1932x1932: 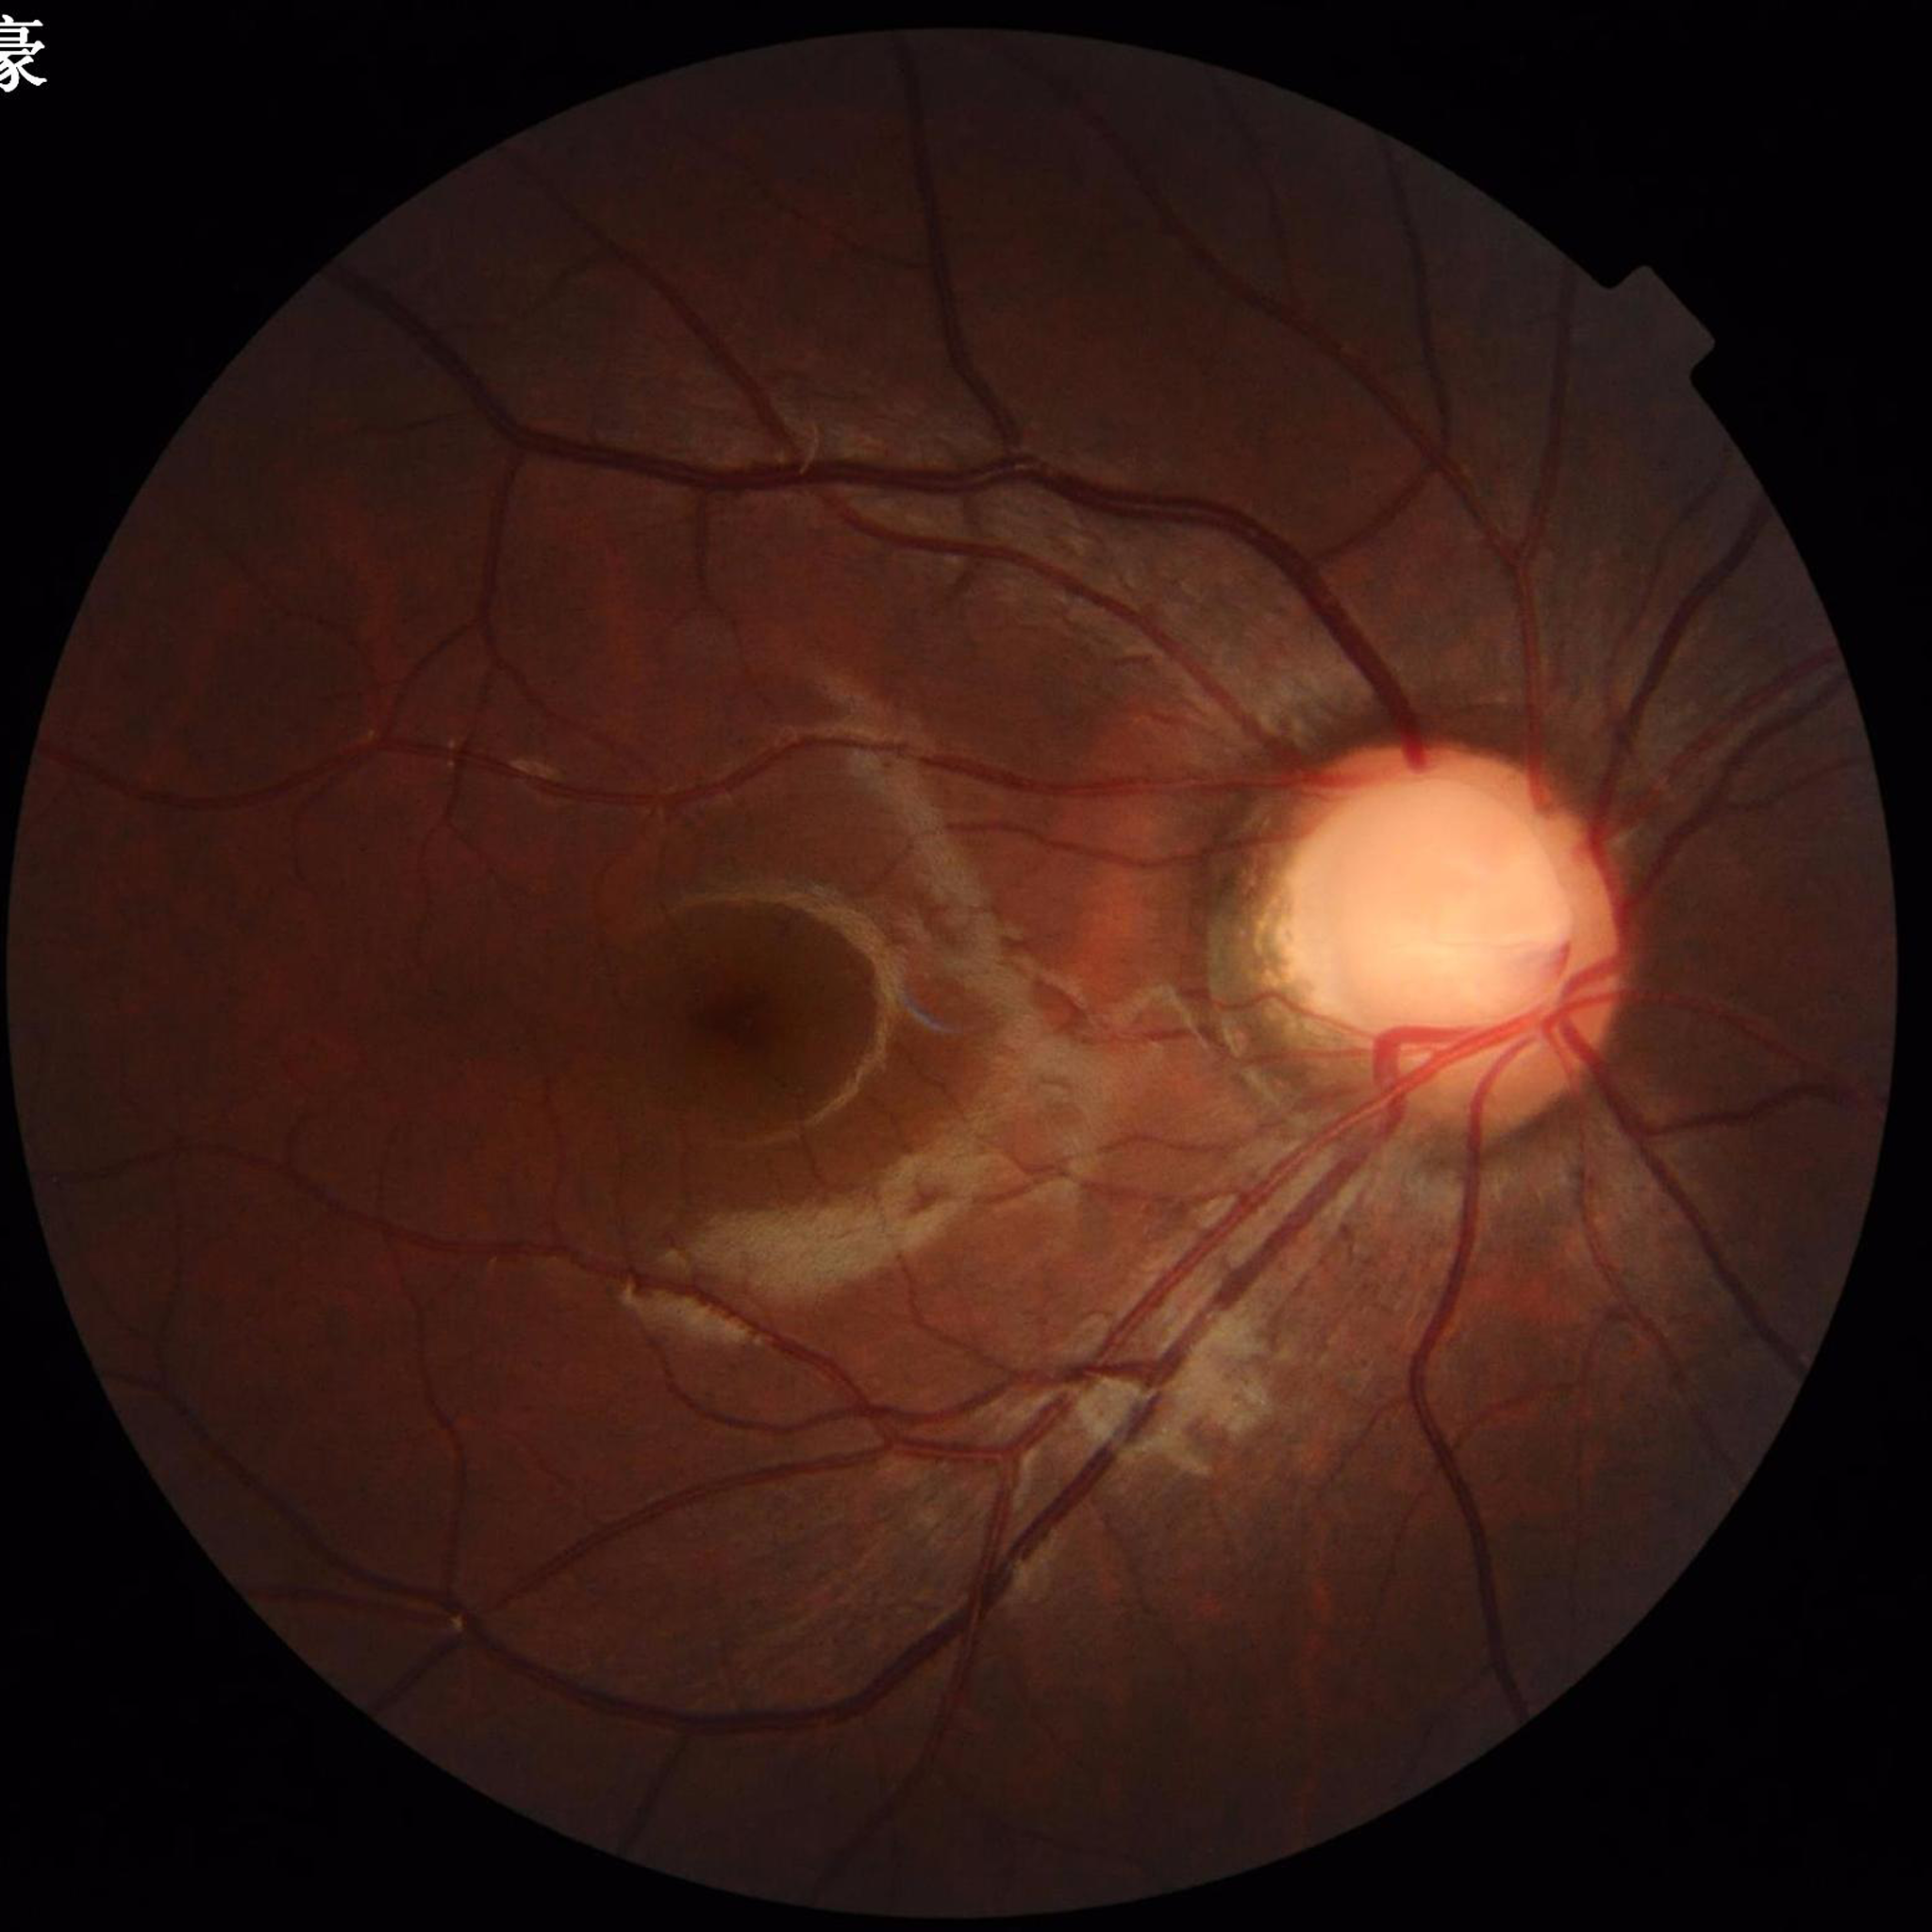 Automated quality assessment: adequate | Condition: glaucoma.